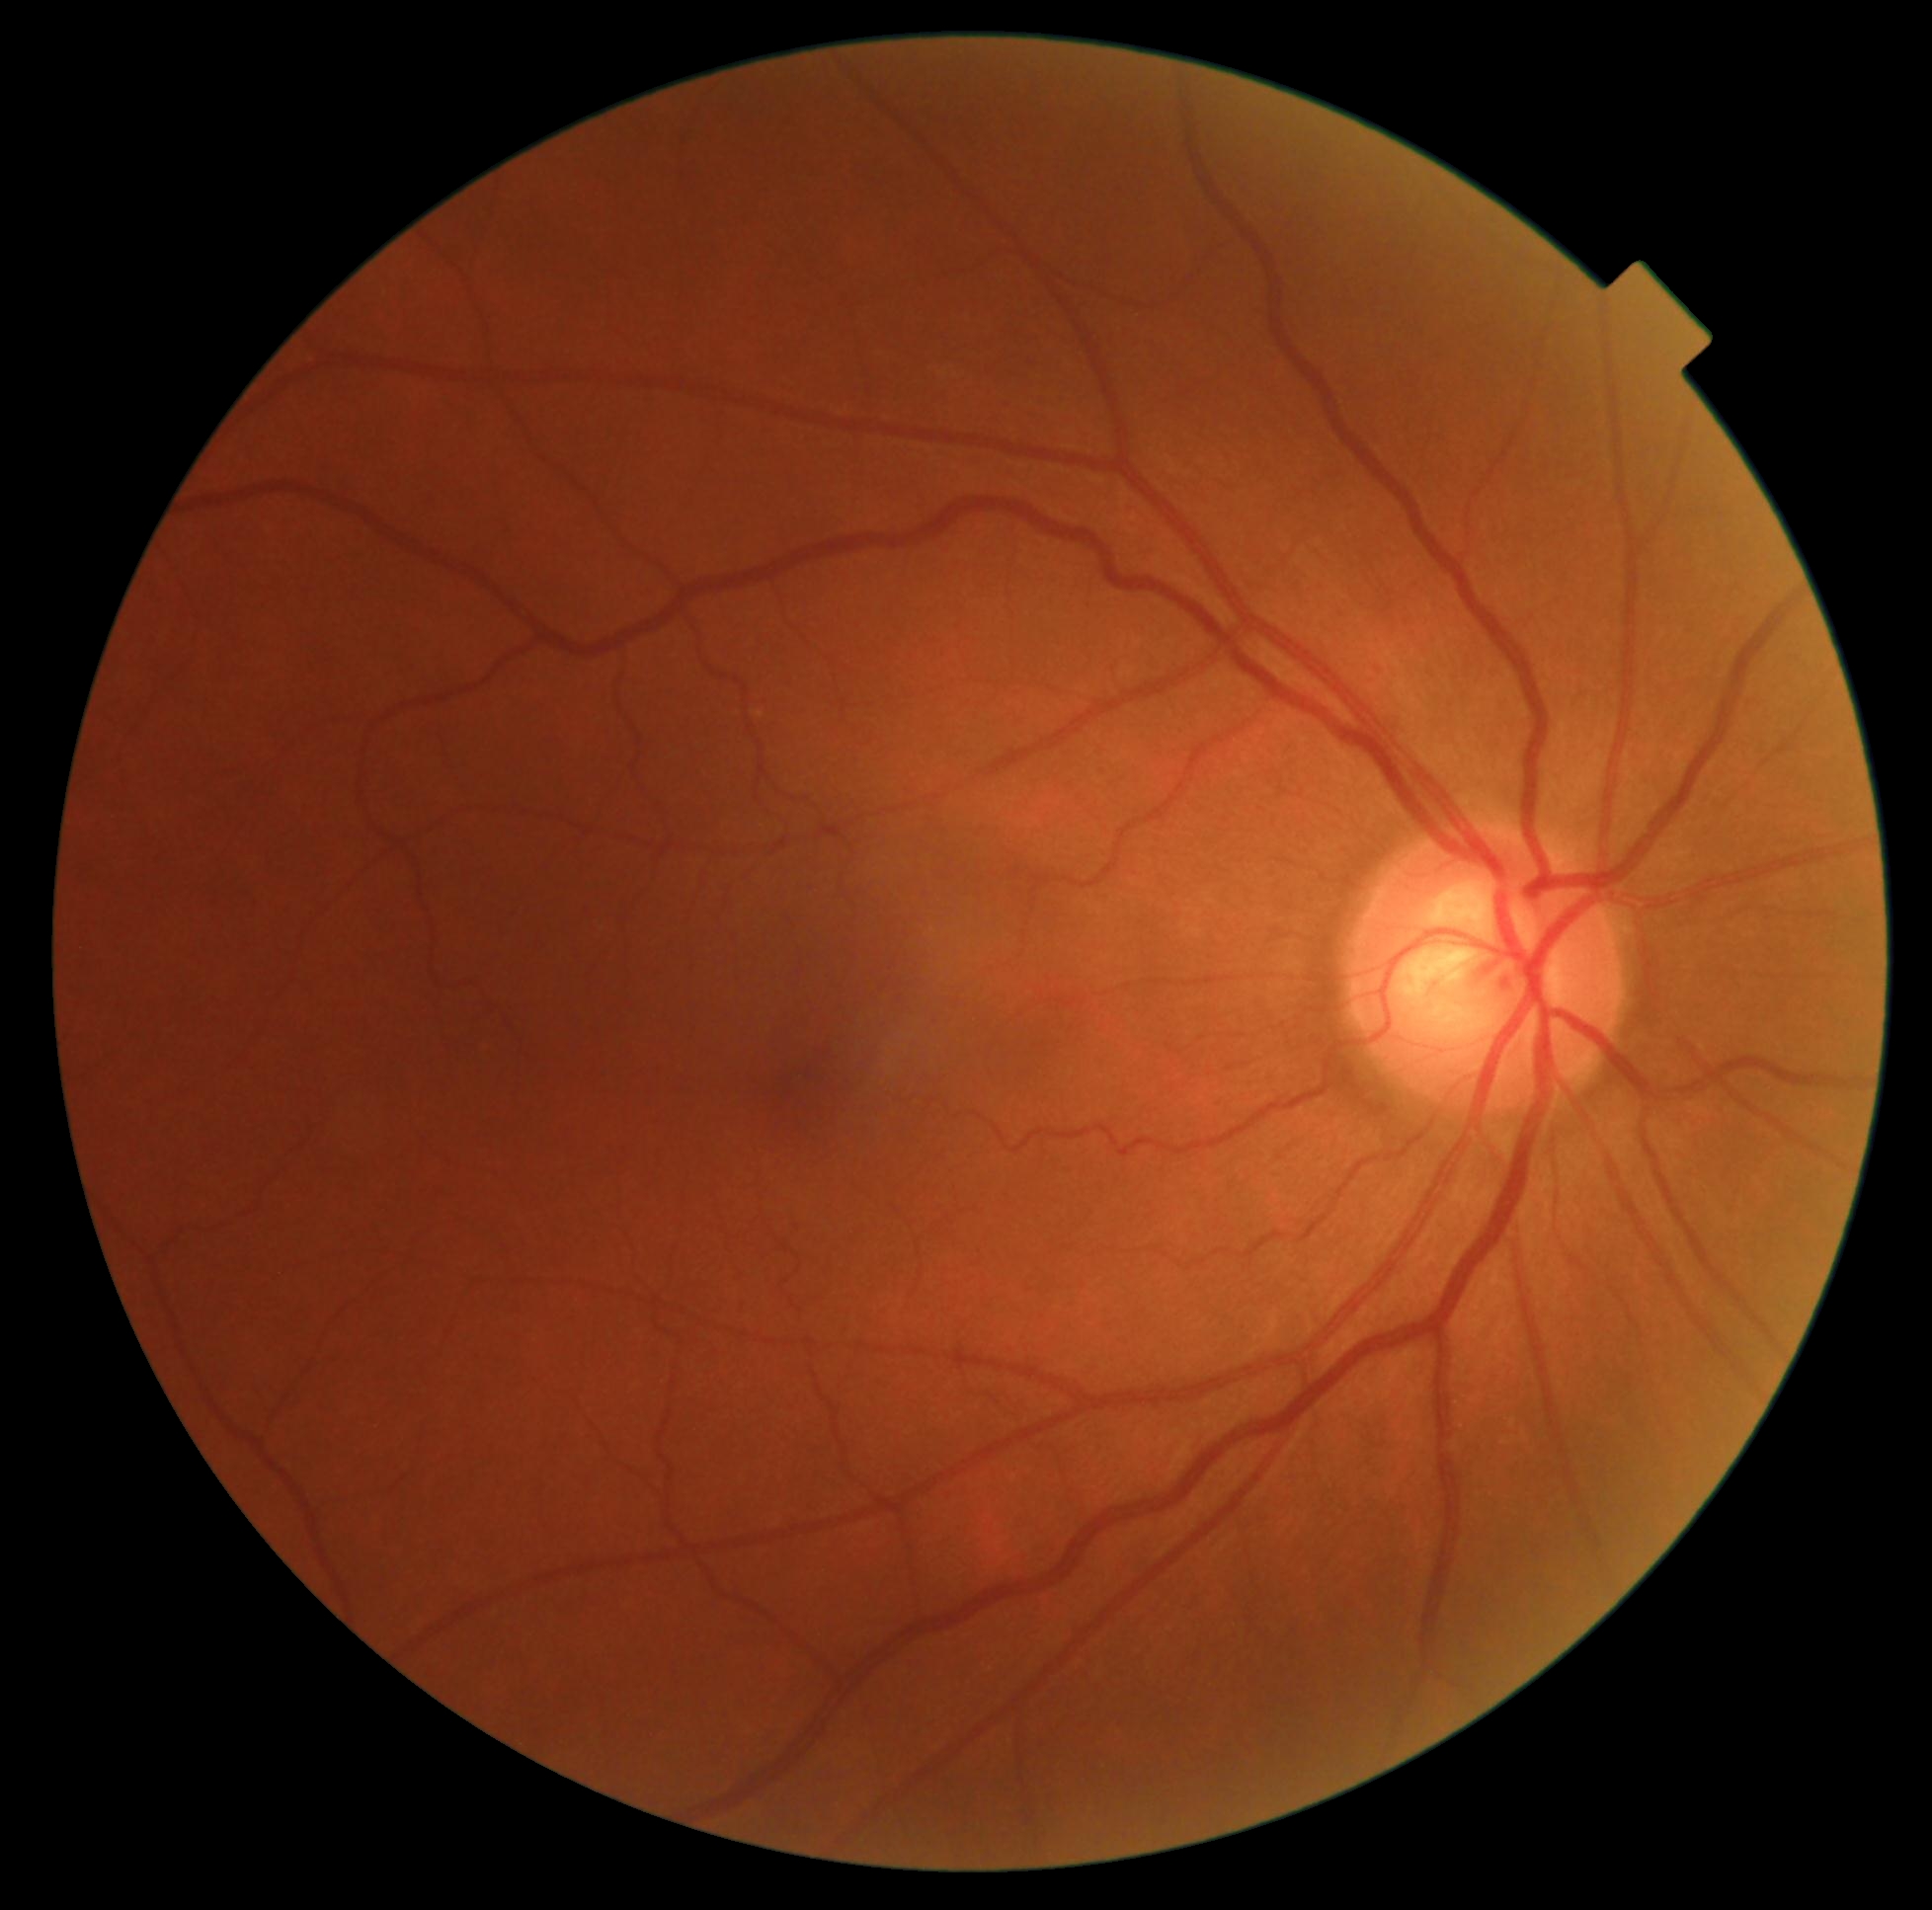

DR impression = no DR findings; diabetic retinopathy (DR) = grade 0.